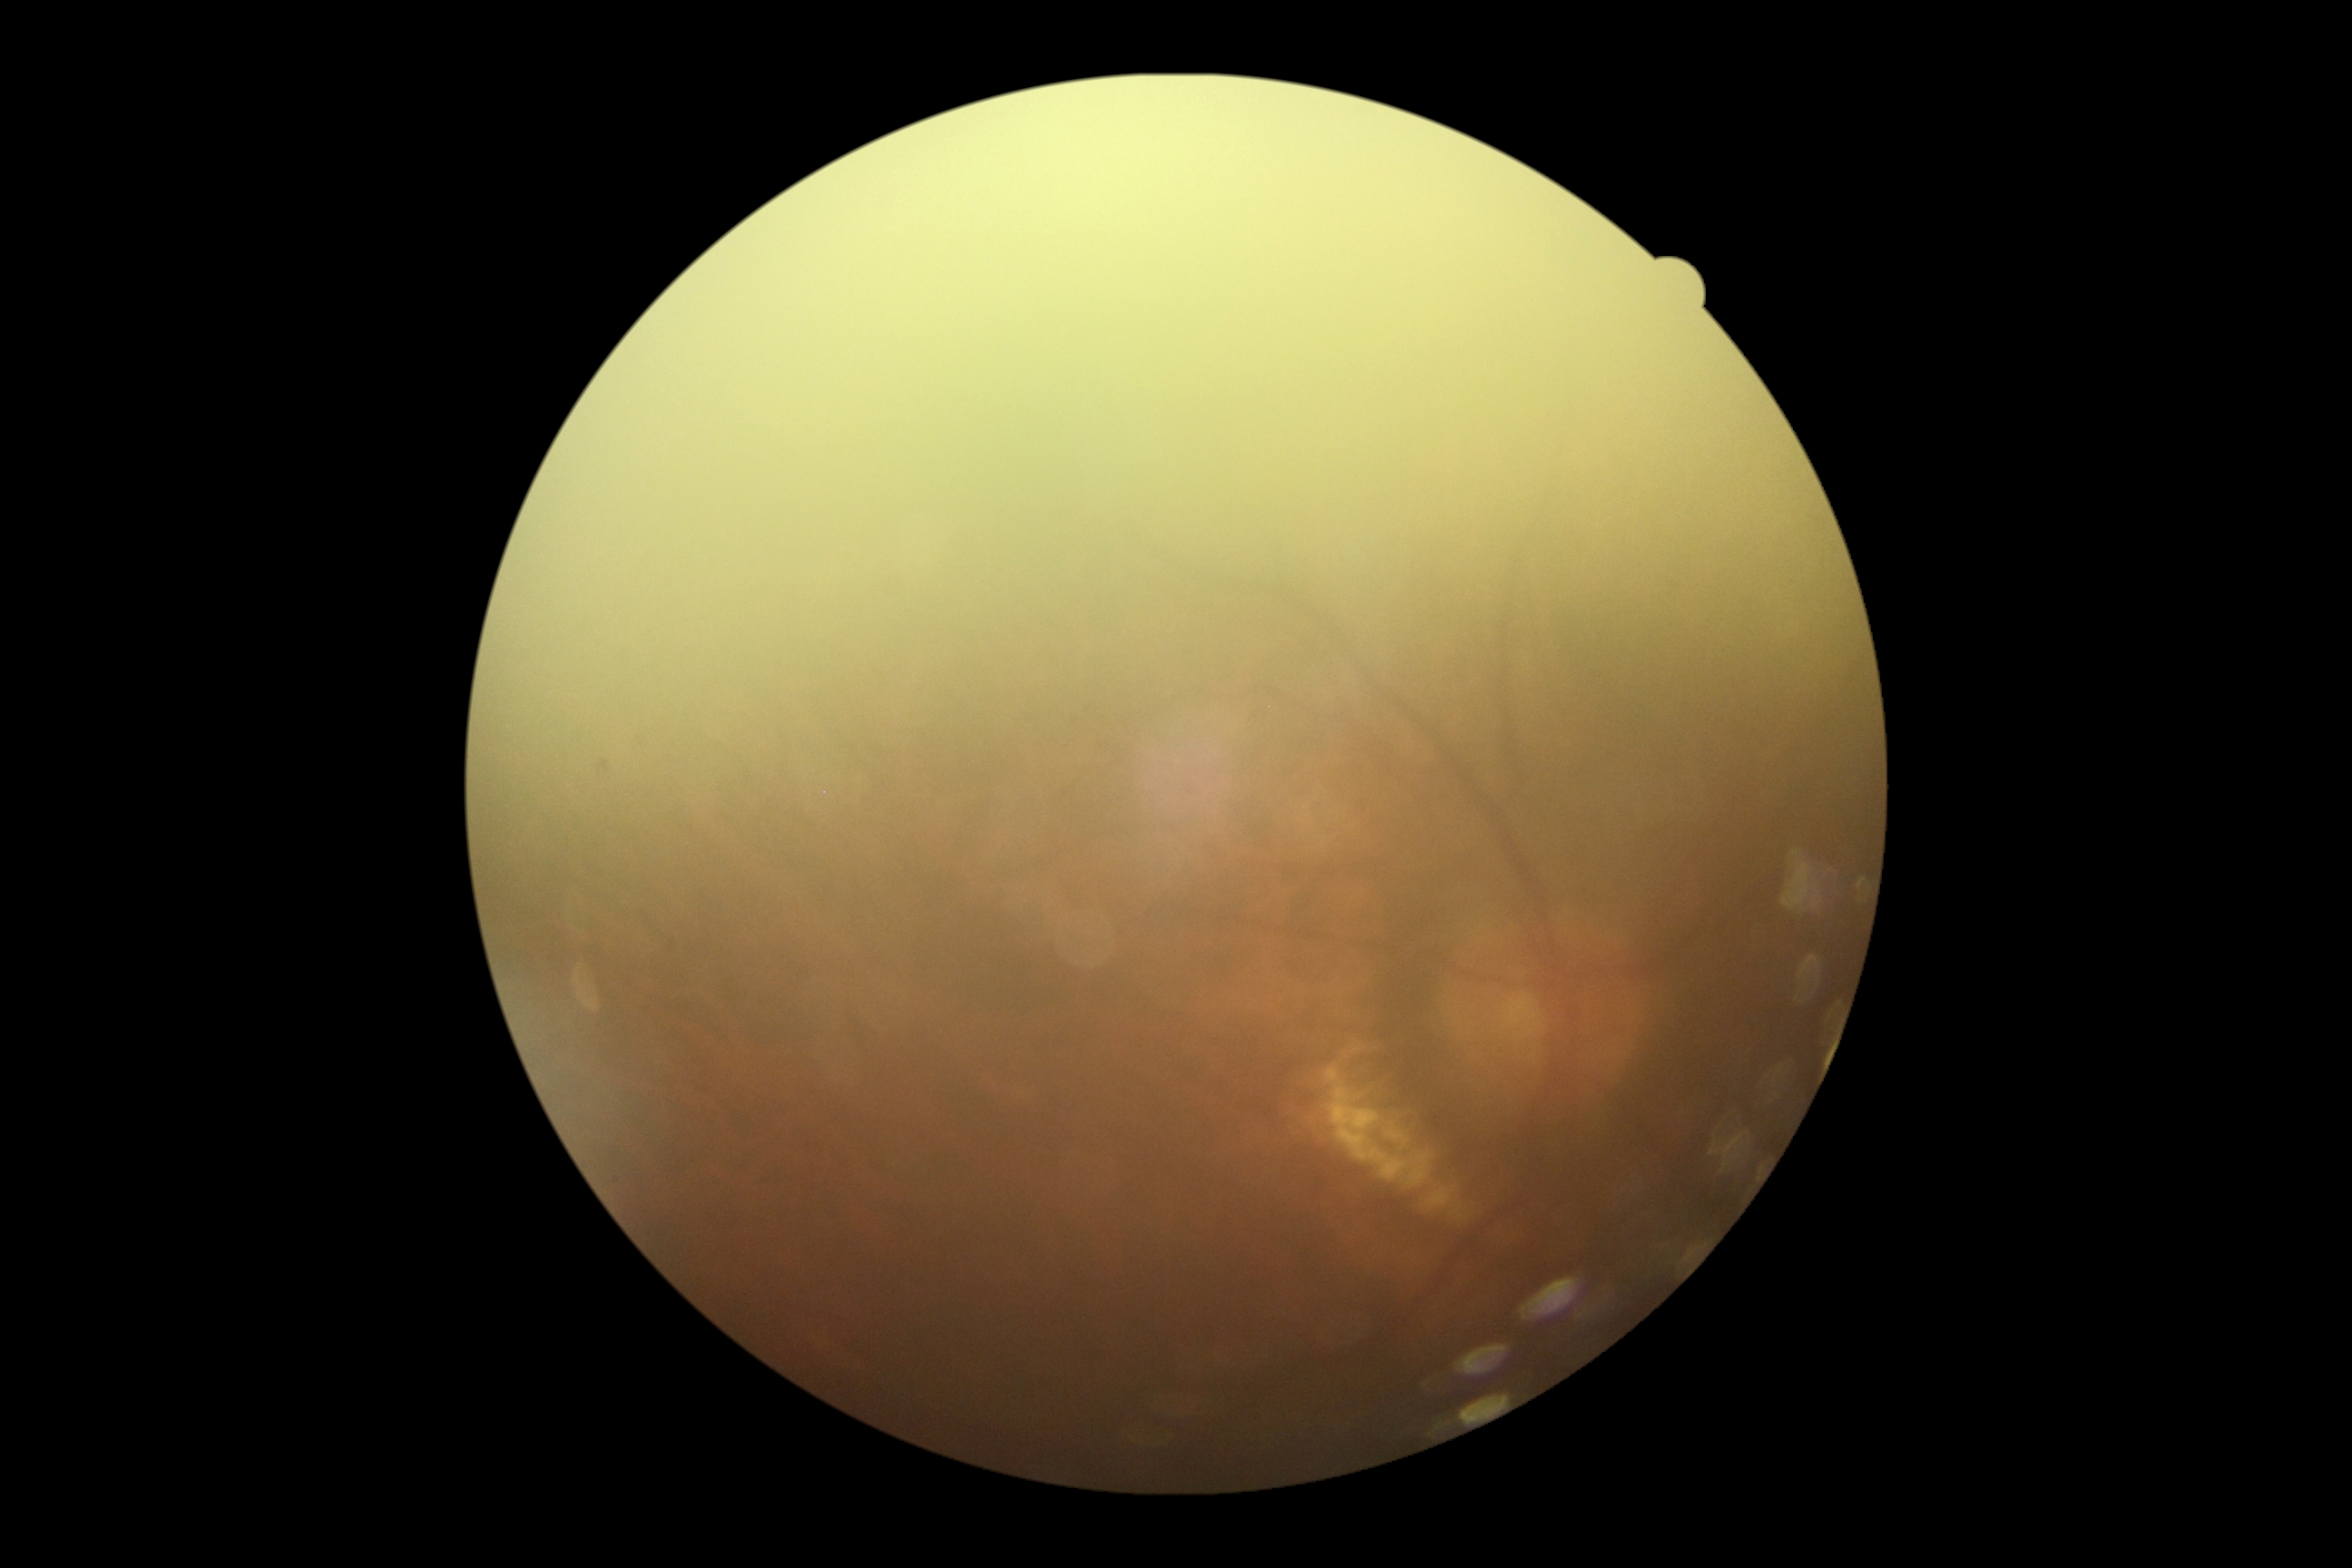 Retinopathy grade: ungradable.